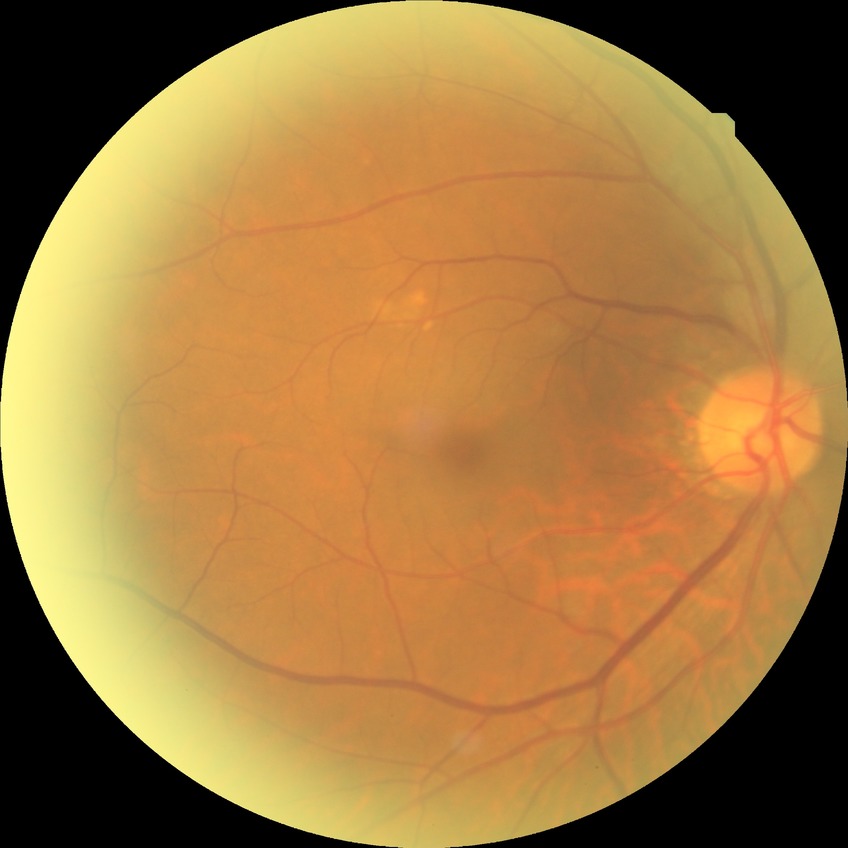
Diabetic retinopathy (DR): no diabetic retinopathy (NDR).